Graded on the modified Davis scale.
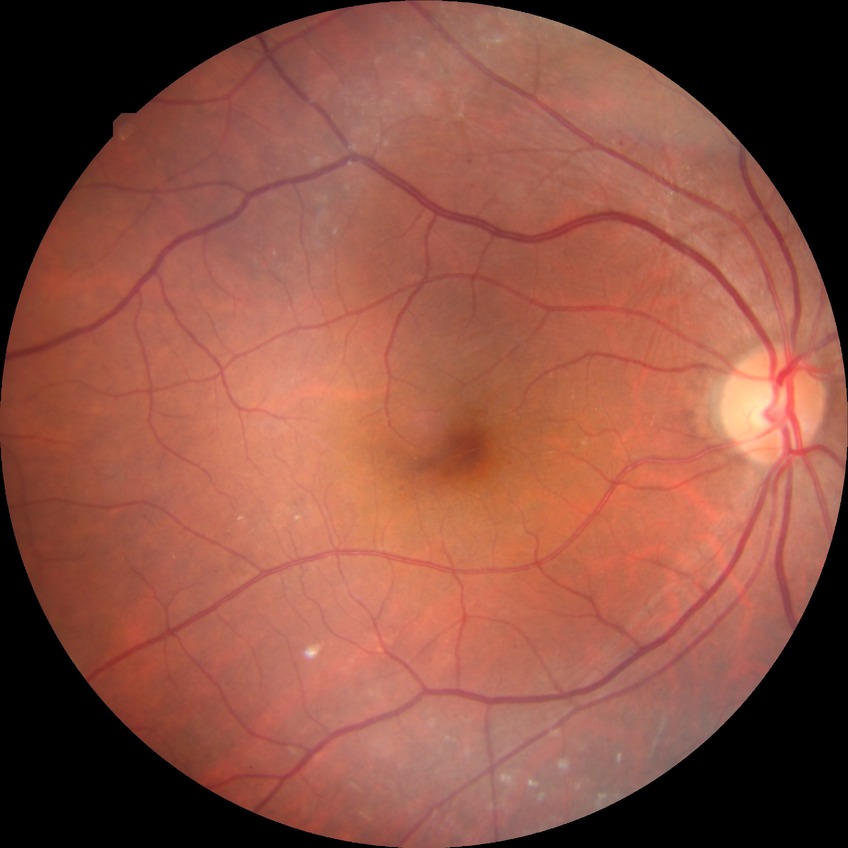 Diabetic retinopathy (DR) is SDR (simple diabetic retinopathy).